FOV: 45 degrees · color fundus photograph.
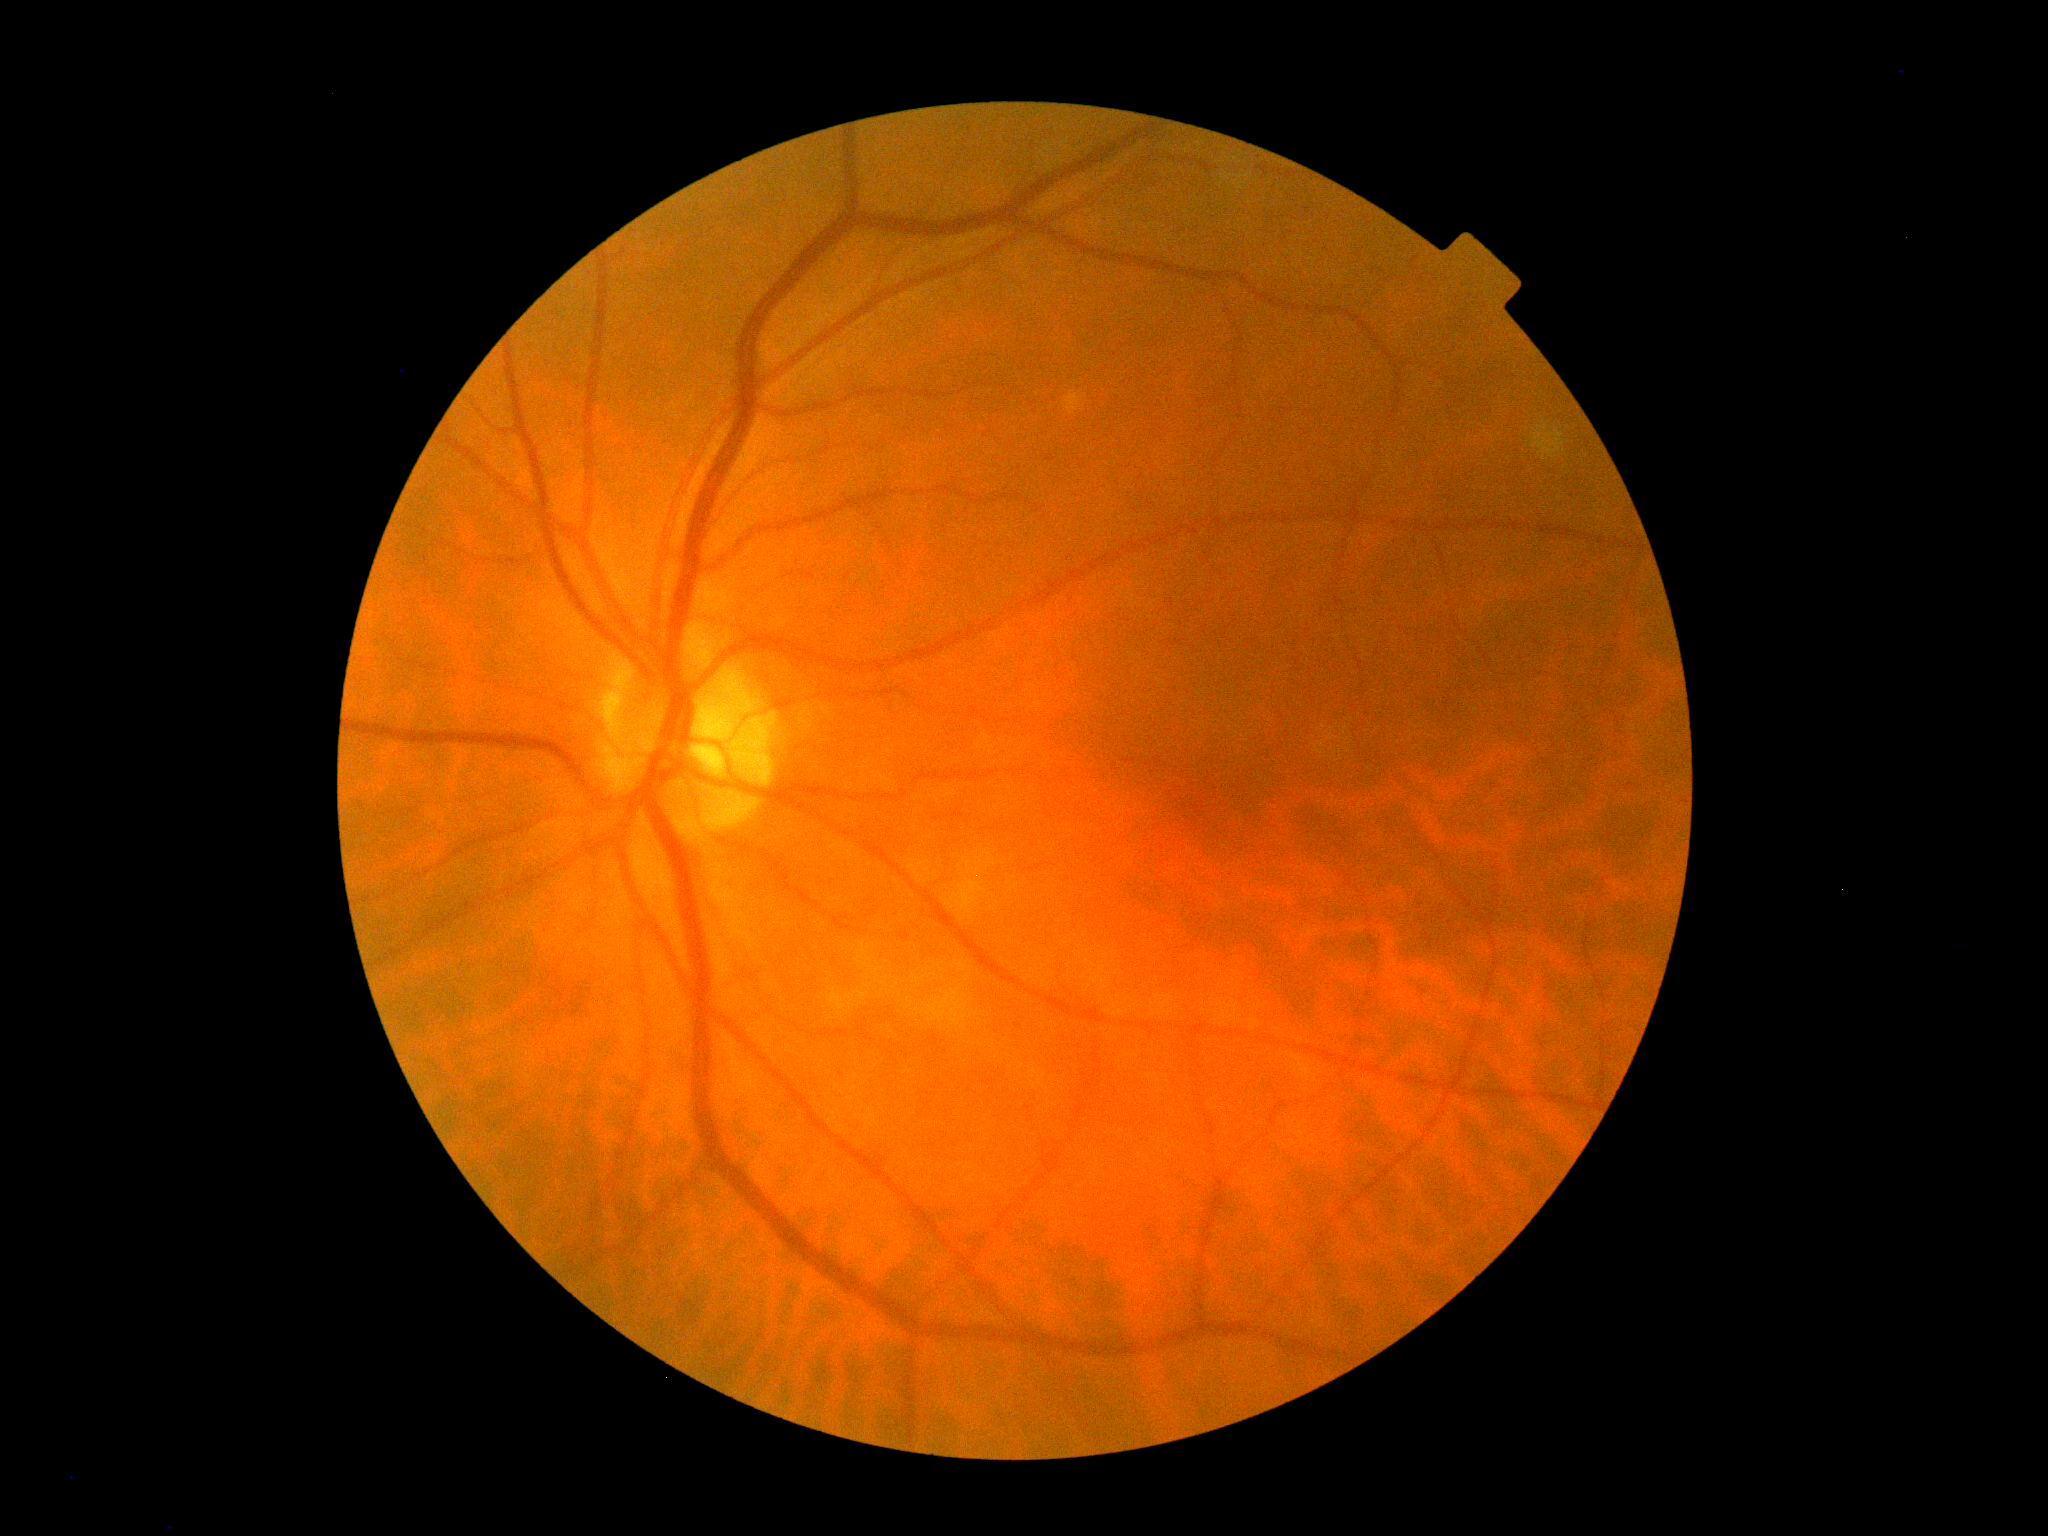 dr_grade: grade 0 (no apparent retinopathy)